Non-mydriatic acquisition · Nidek AFC-330.
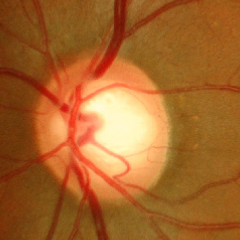
Color fundus photograph showing early glaucomatous optic neuropathy.